45-degree field of view.
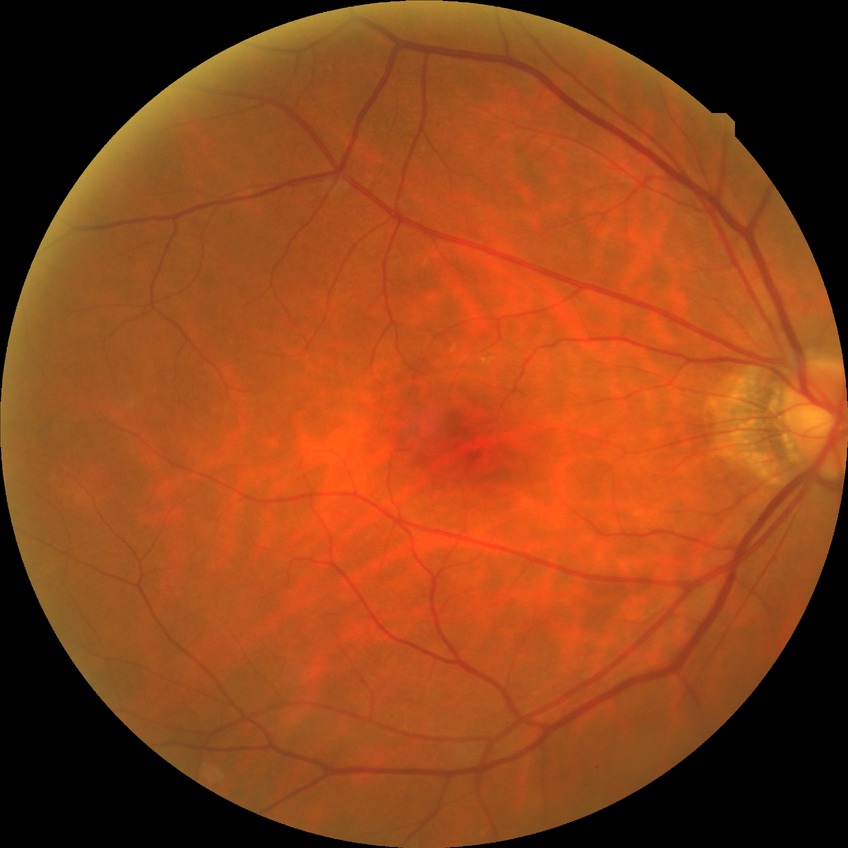

davis_grade: no diabetic retinopathy (NDR)